Image size 1920x1440, captured on a Bosch handheld camera, color fundus photograph:
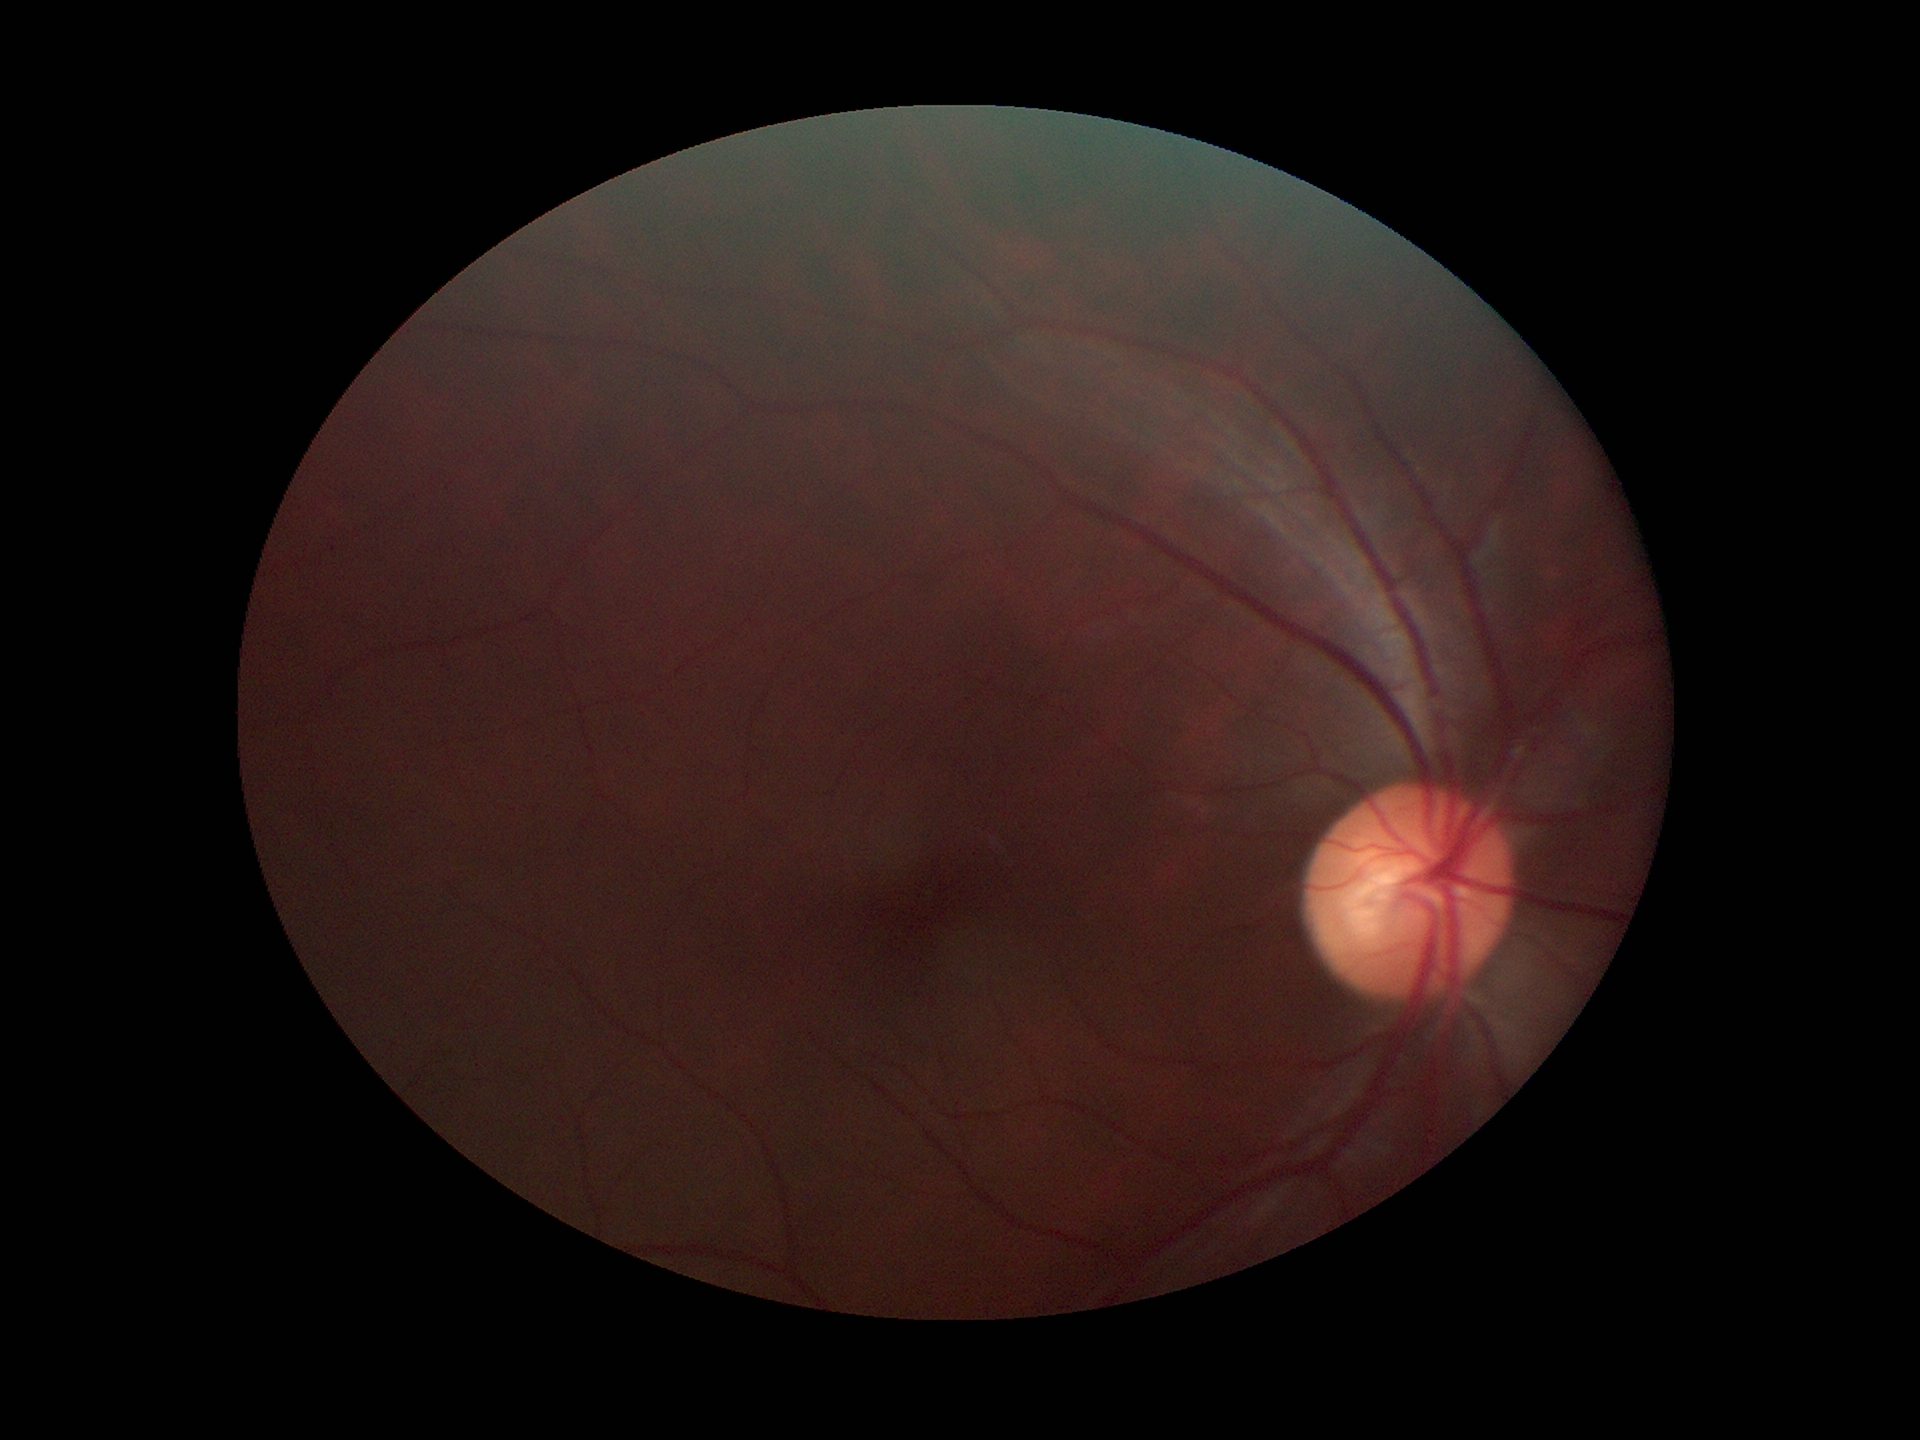

vertical cup-to-disc ratio (VCDR) = 0.54; Glaucoma impression = not suspect.